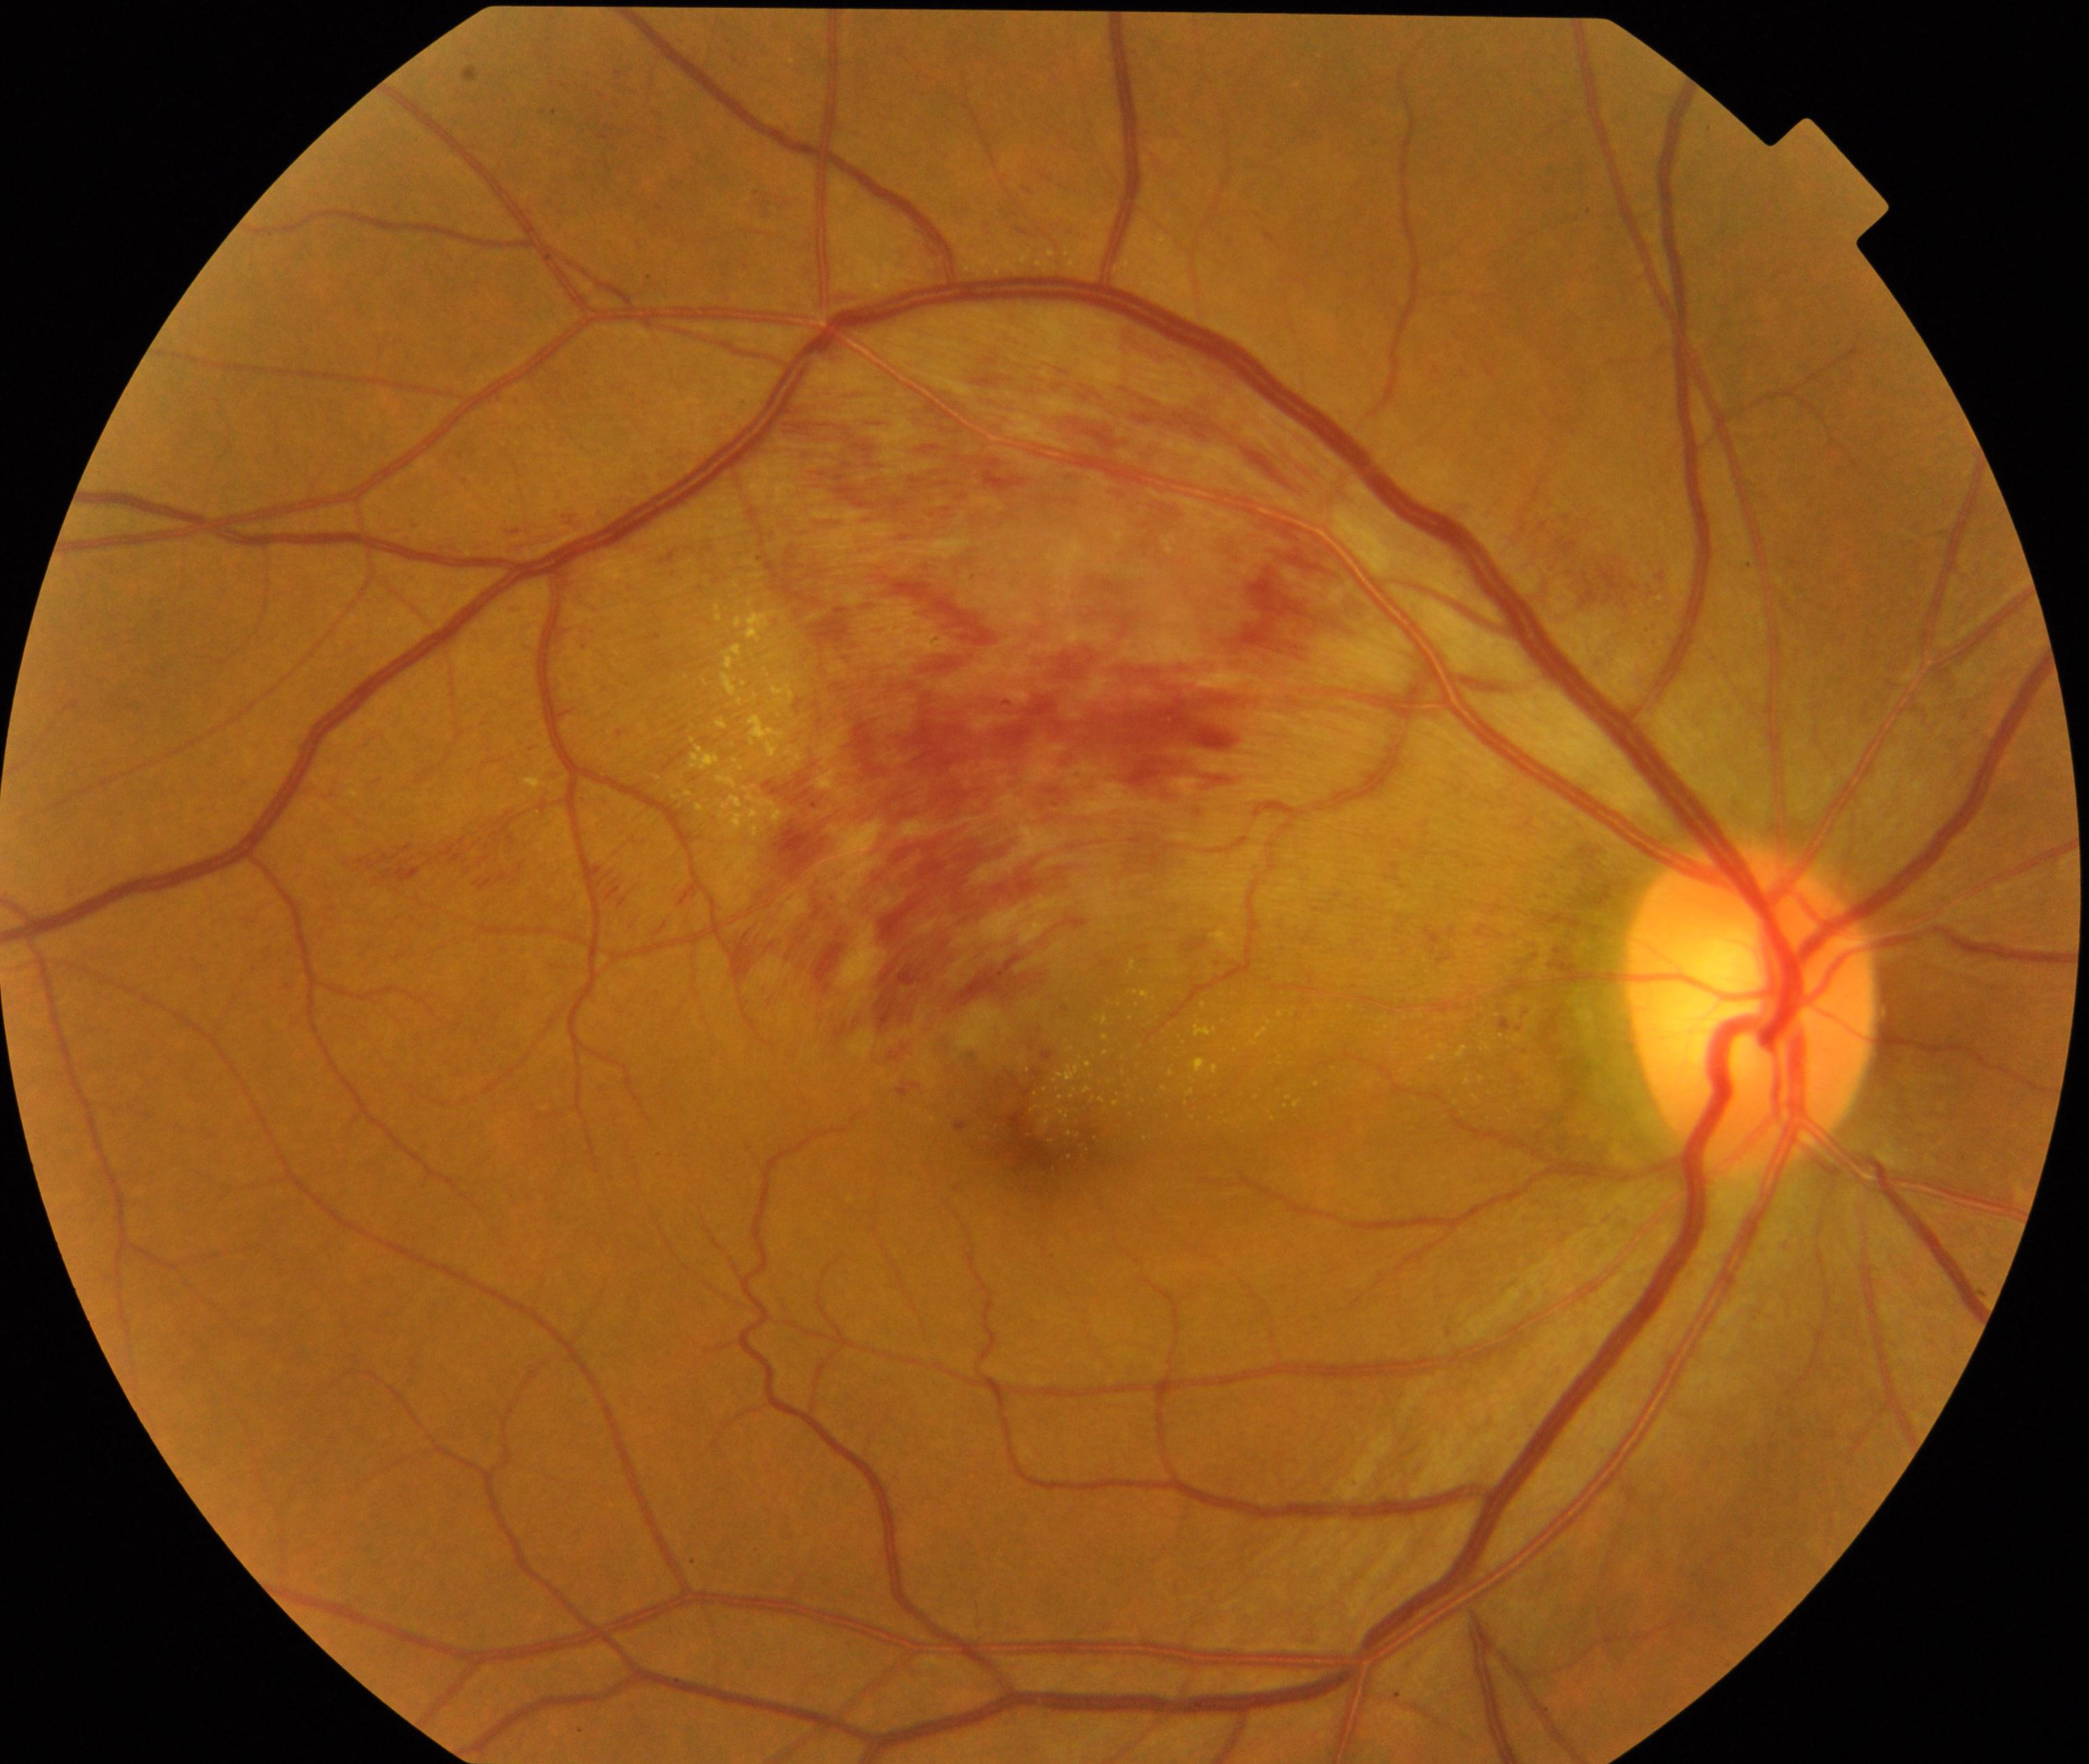
The image shows BRVO (branch retinal vein occlusion). Characterized by tortuosity and dilatation of affected veins, with dot, blot, and flame hemorrhages, sometimes with cotton-wool spots or hard exudates.